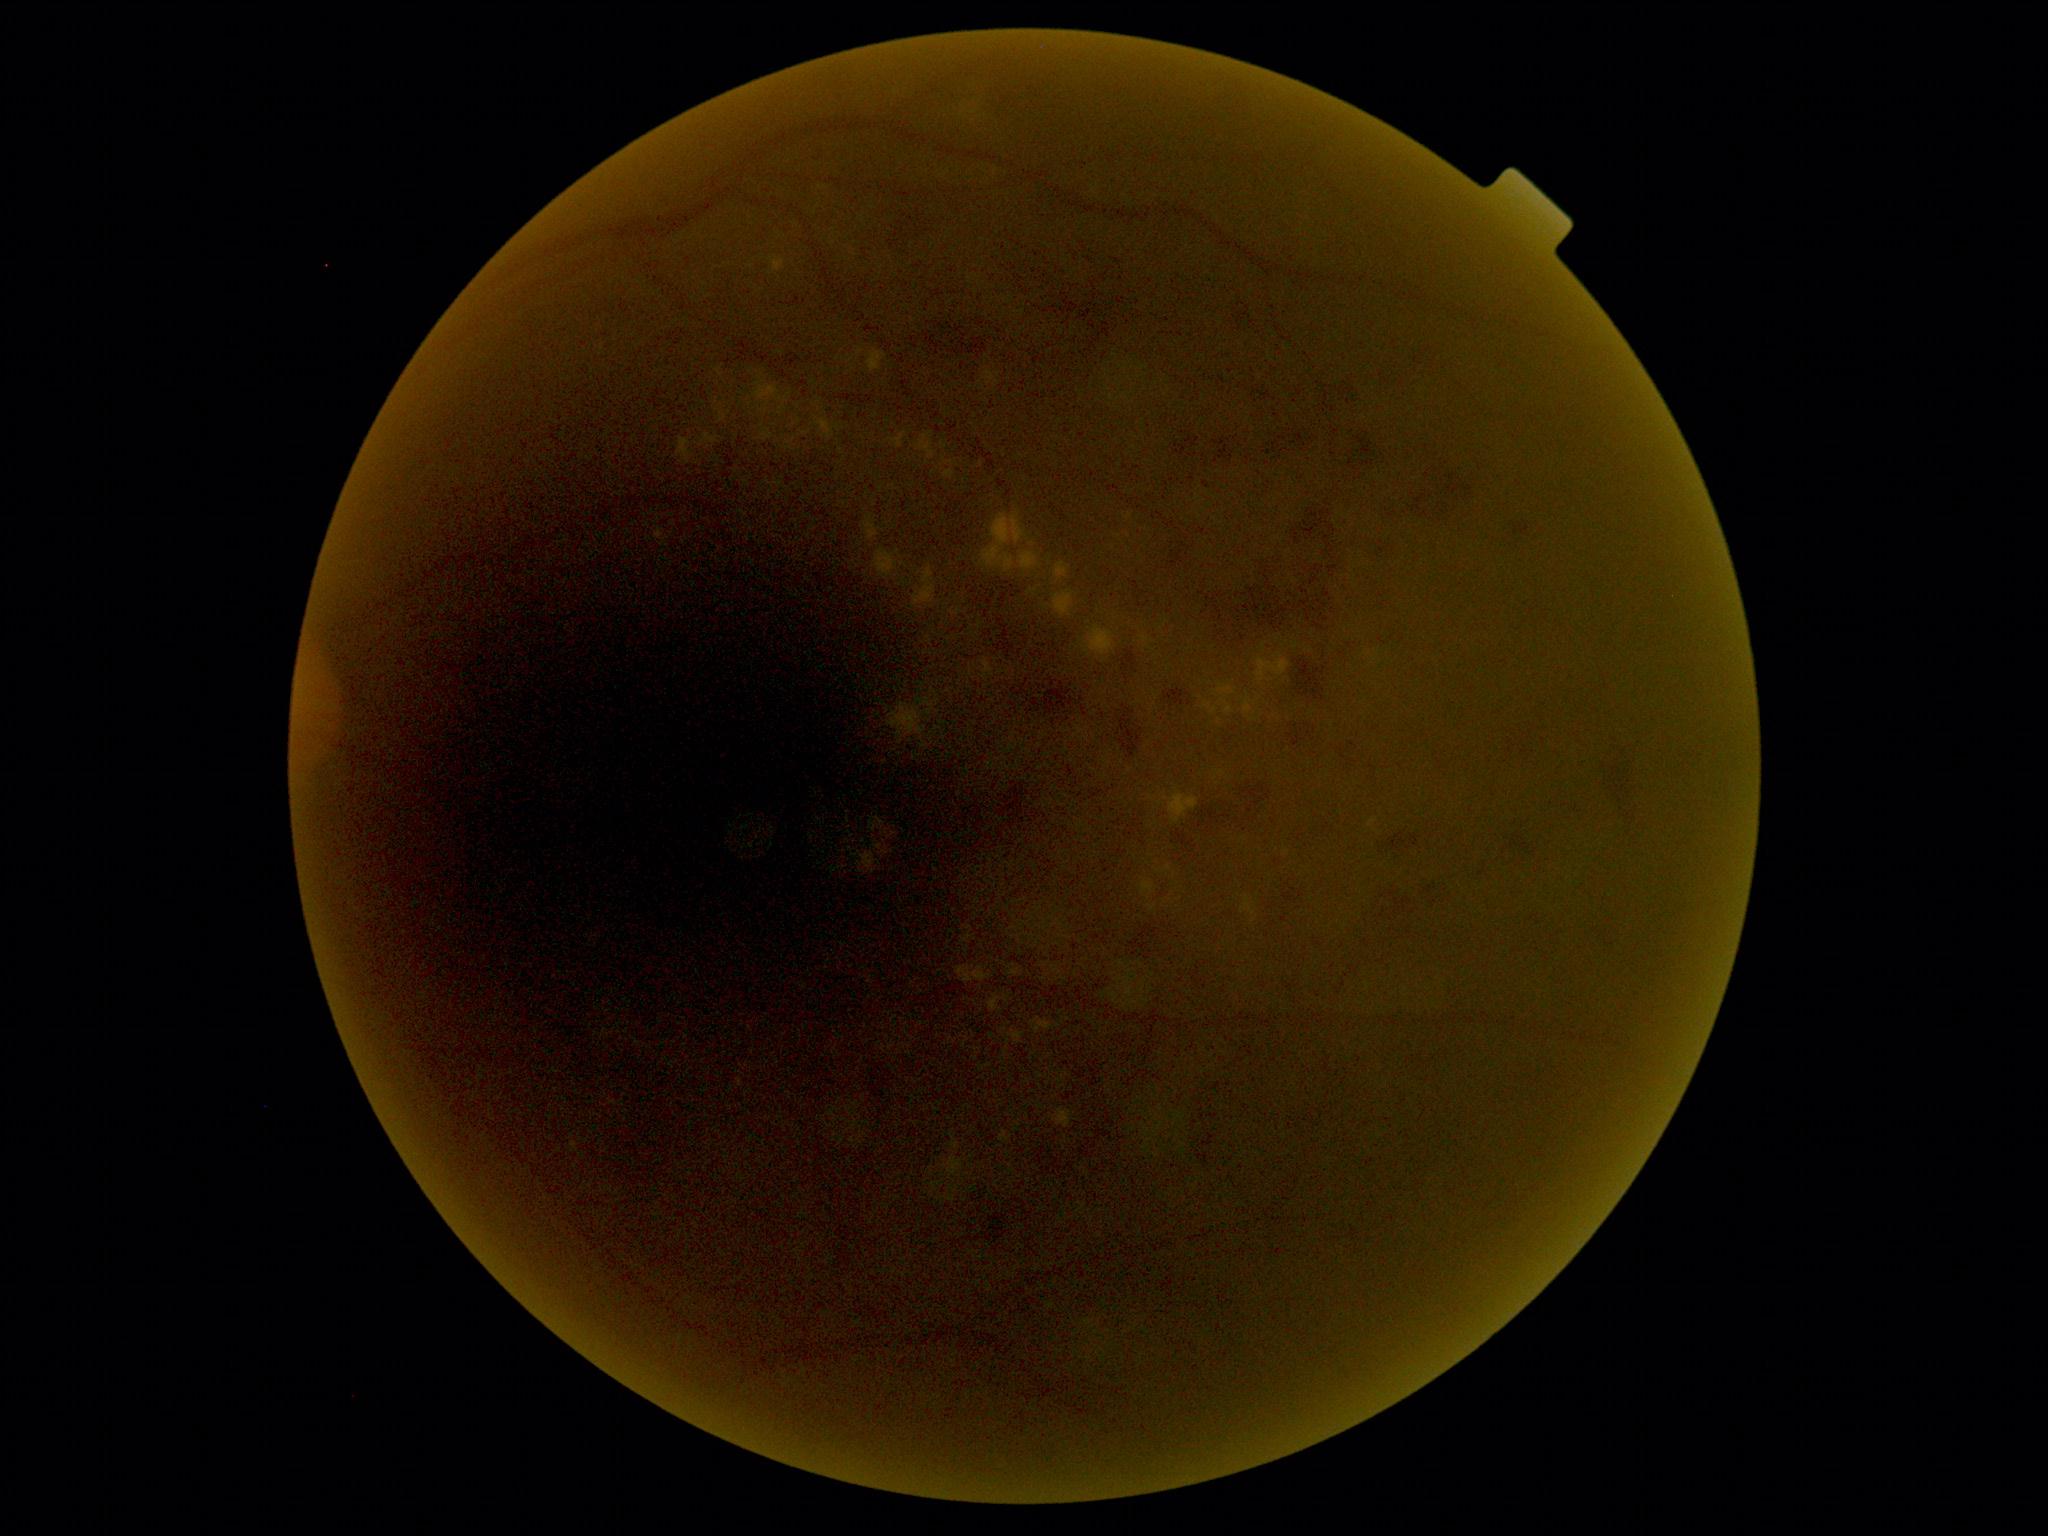 DR: severe NPDR (grade 3) — more than 20 intraretinal hemorrhages in each of 4 quadrants, definite venous beading in 2 or more quadrants, or prominent intraretinal microvascular abnormalities in 1 or more quadrants, with no signs of proliferative retinopathy.